45-degree field of view. Retinal fundus photograph
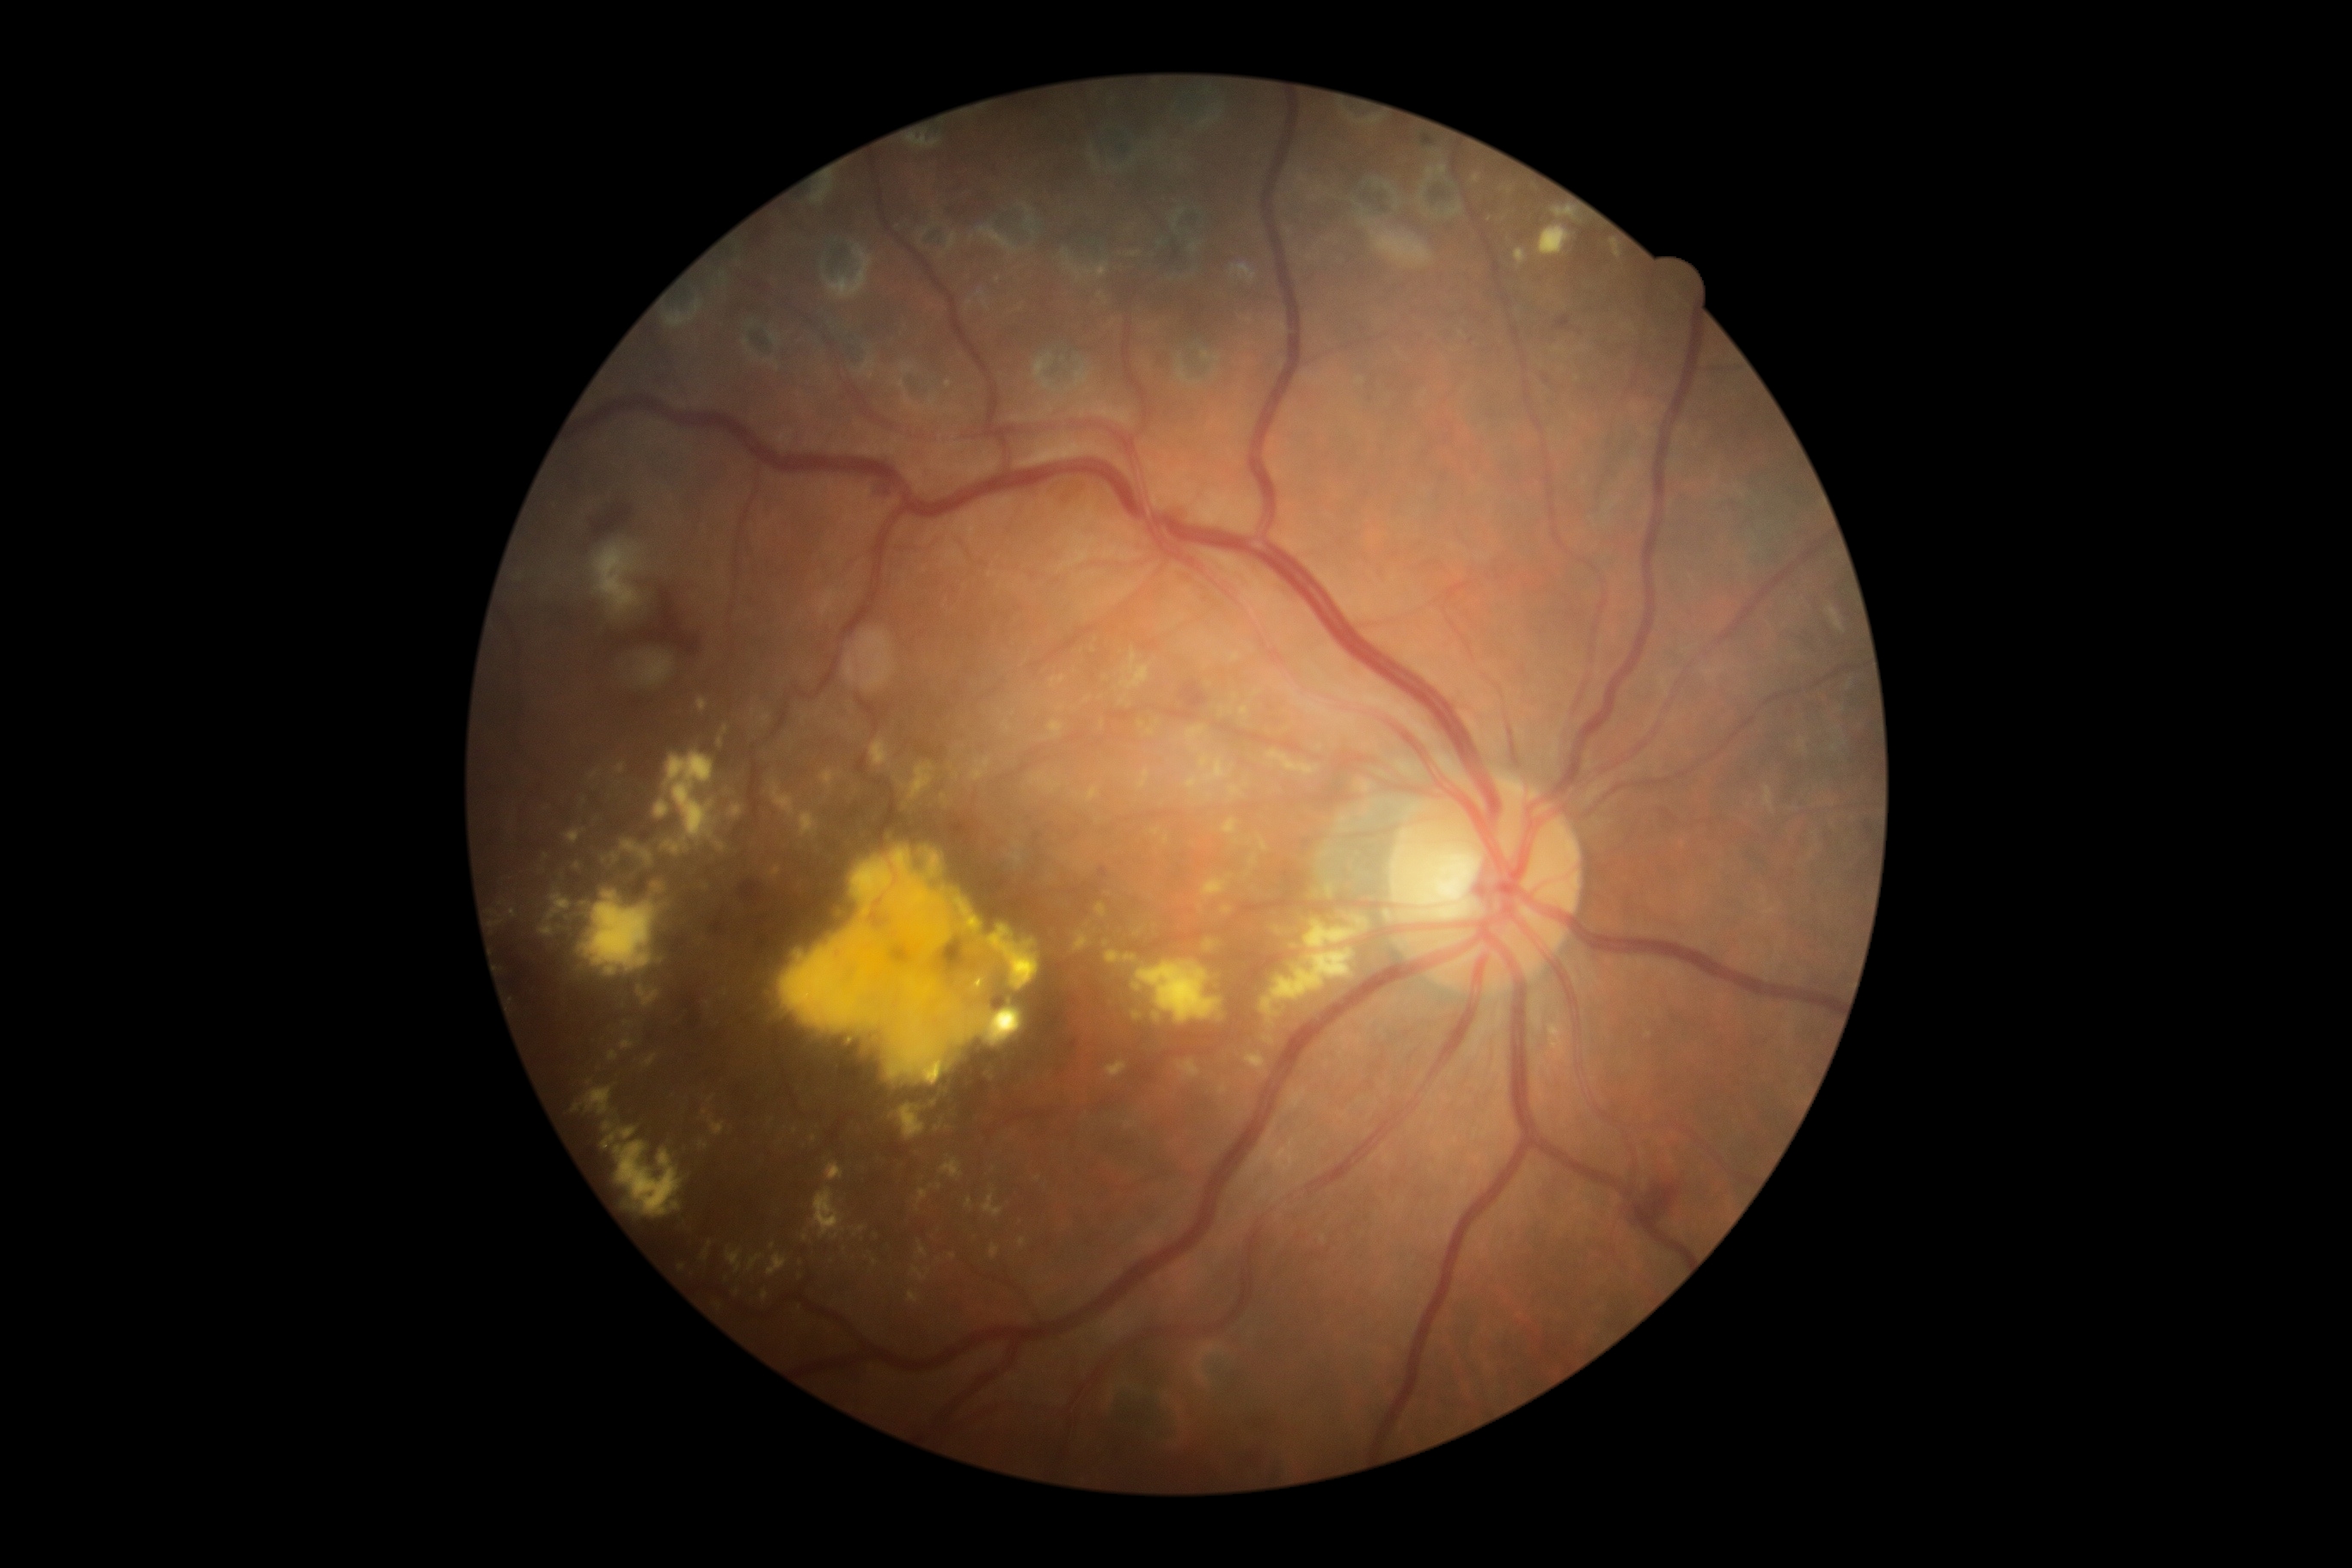
DR is moderate NPDR (grade 2).